Color fundus photograph, non-mydriatic, centered on the optic disc
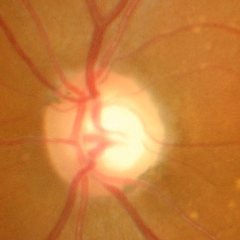
Glaucoma stage = advanced glaucoma. (Criteria: near-total cupping of the optic nerve head, with or without severe visual field loss within the central 10 degrees of fixation.)